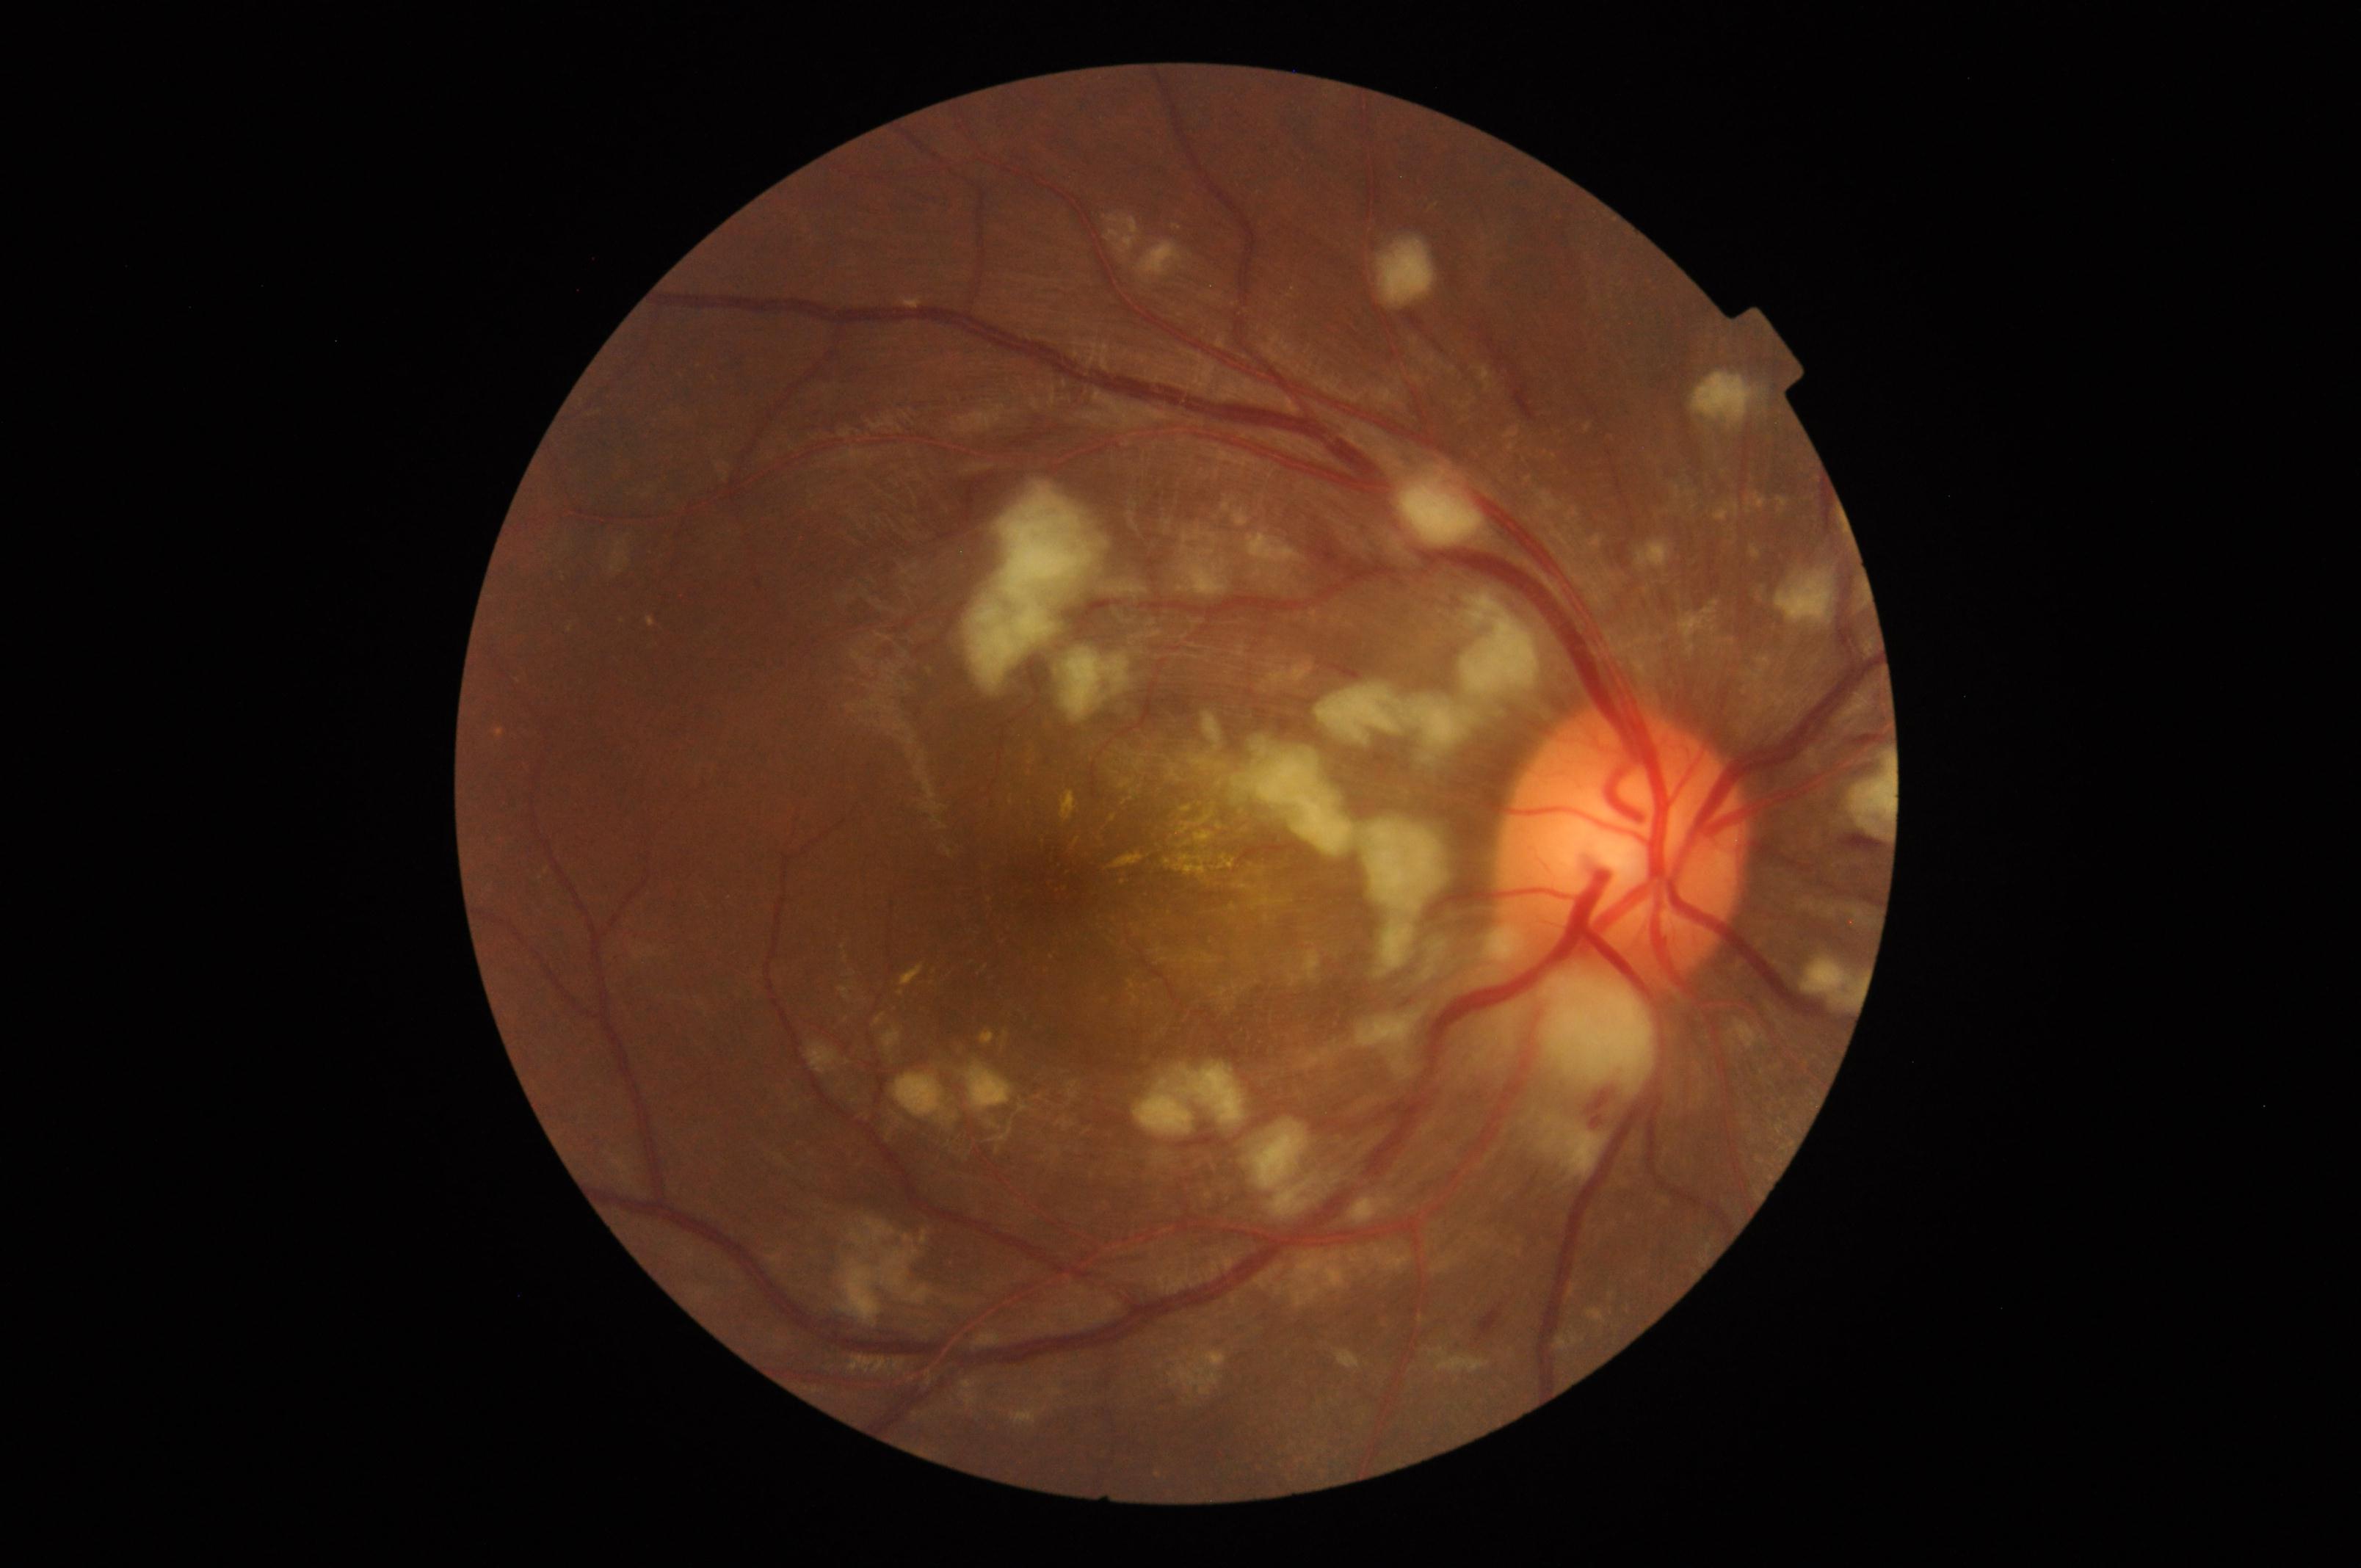
Findings: severe hypertensive retinopathy.